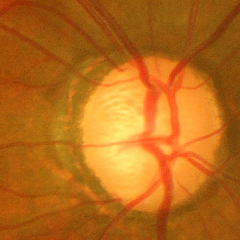
Findings consistent with glaucoma. Showing advanced glaucoma.